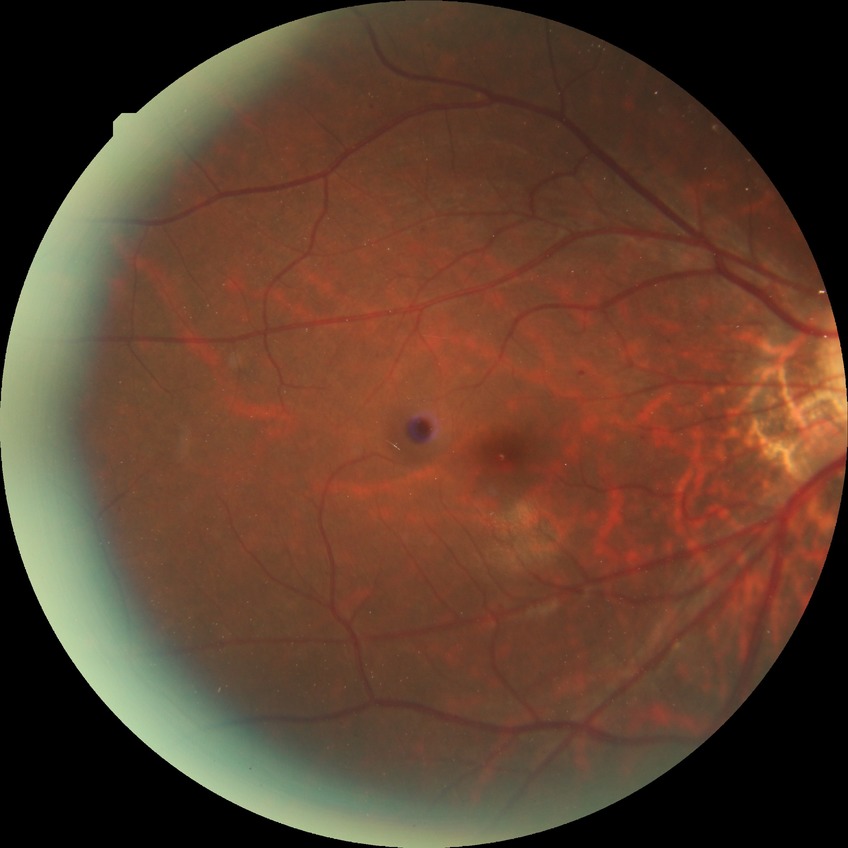

Diabetic retinopathy (DR): simple diabetic retinopathy (SDR).